Wide-field retinal mosaic image.
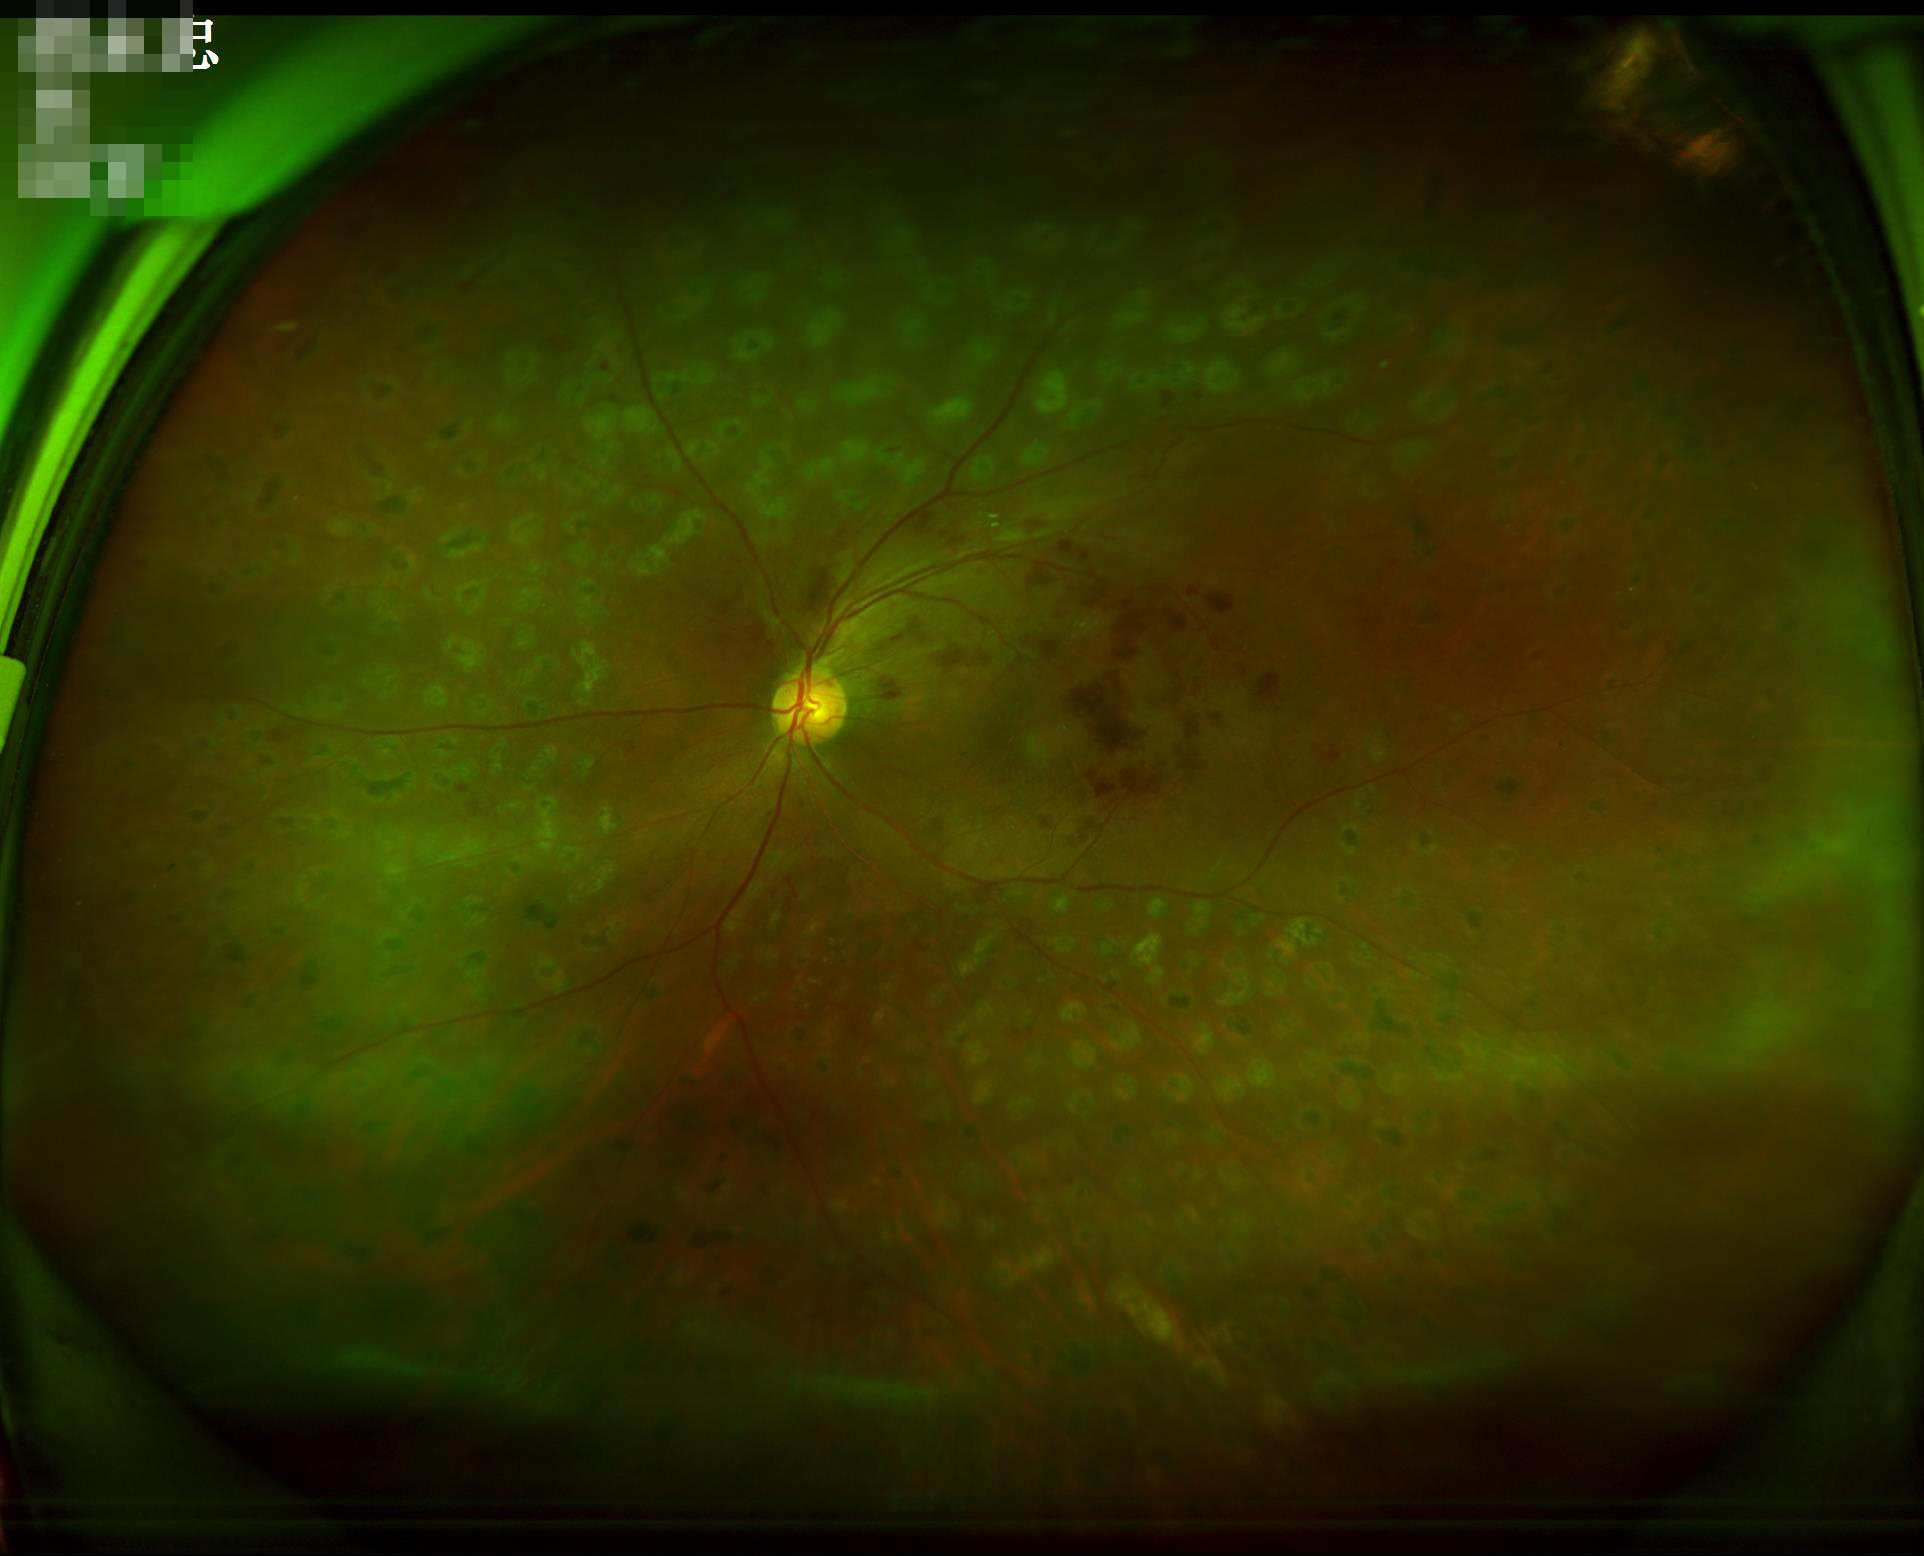 {
  "clarity": "reduced sharpness with visible blur",
  "overall_quality": "adequate for clinical interpretation",
  "contrast": "vessels and details readily distinguishable"
}